FOV: 45 degrees; color fundus image
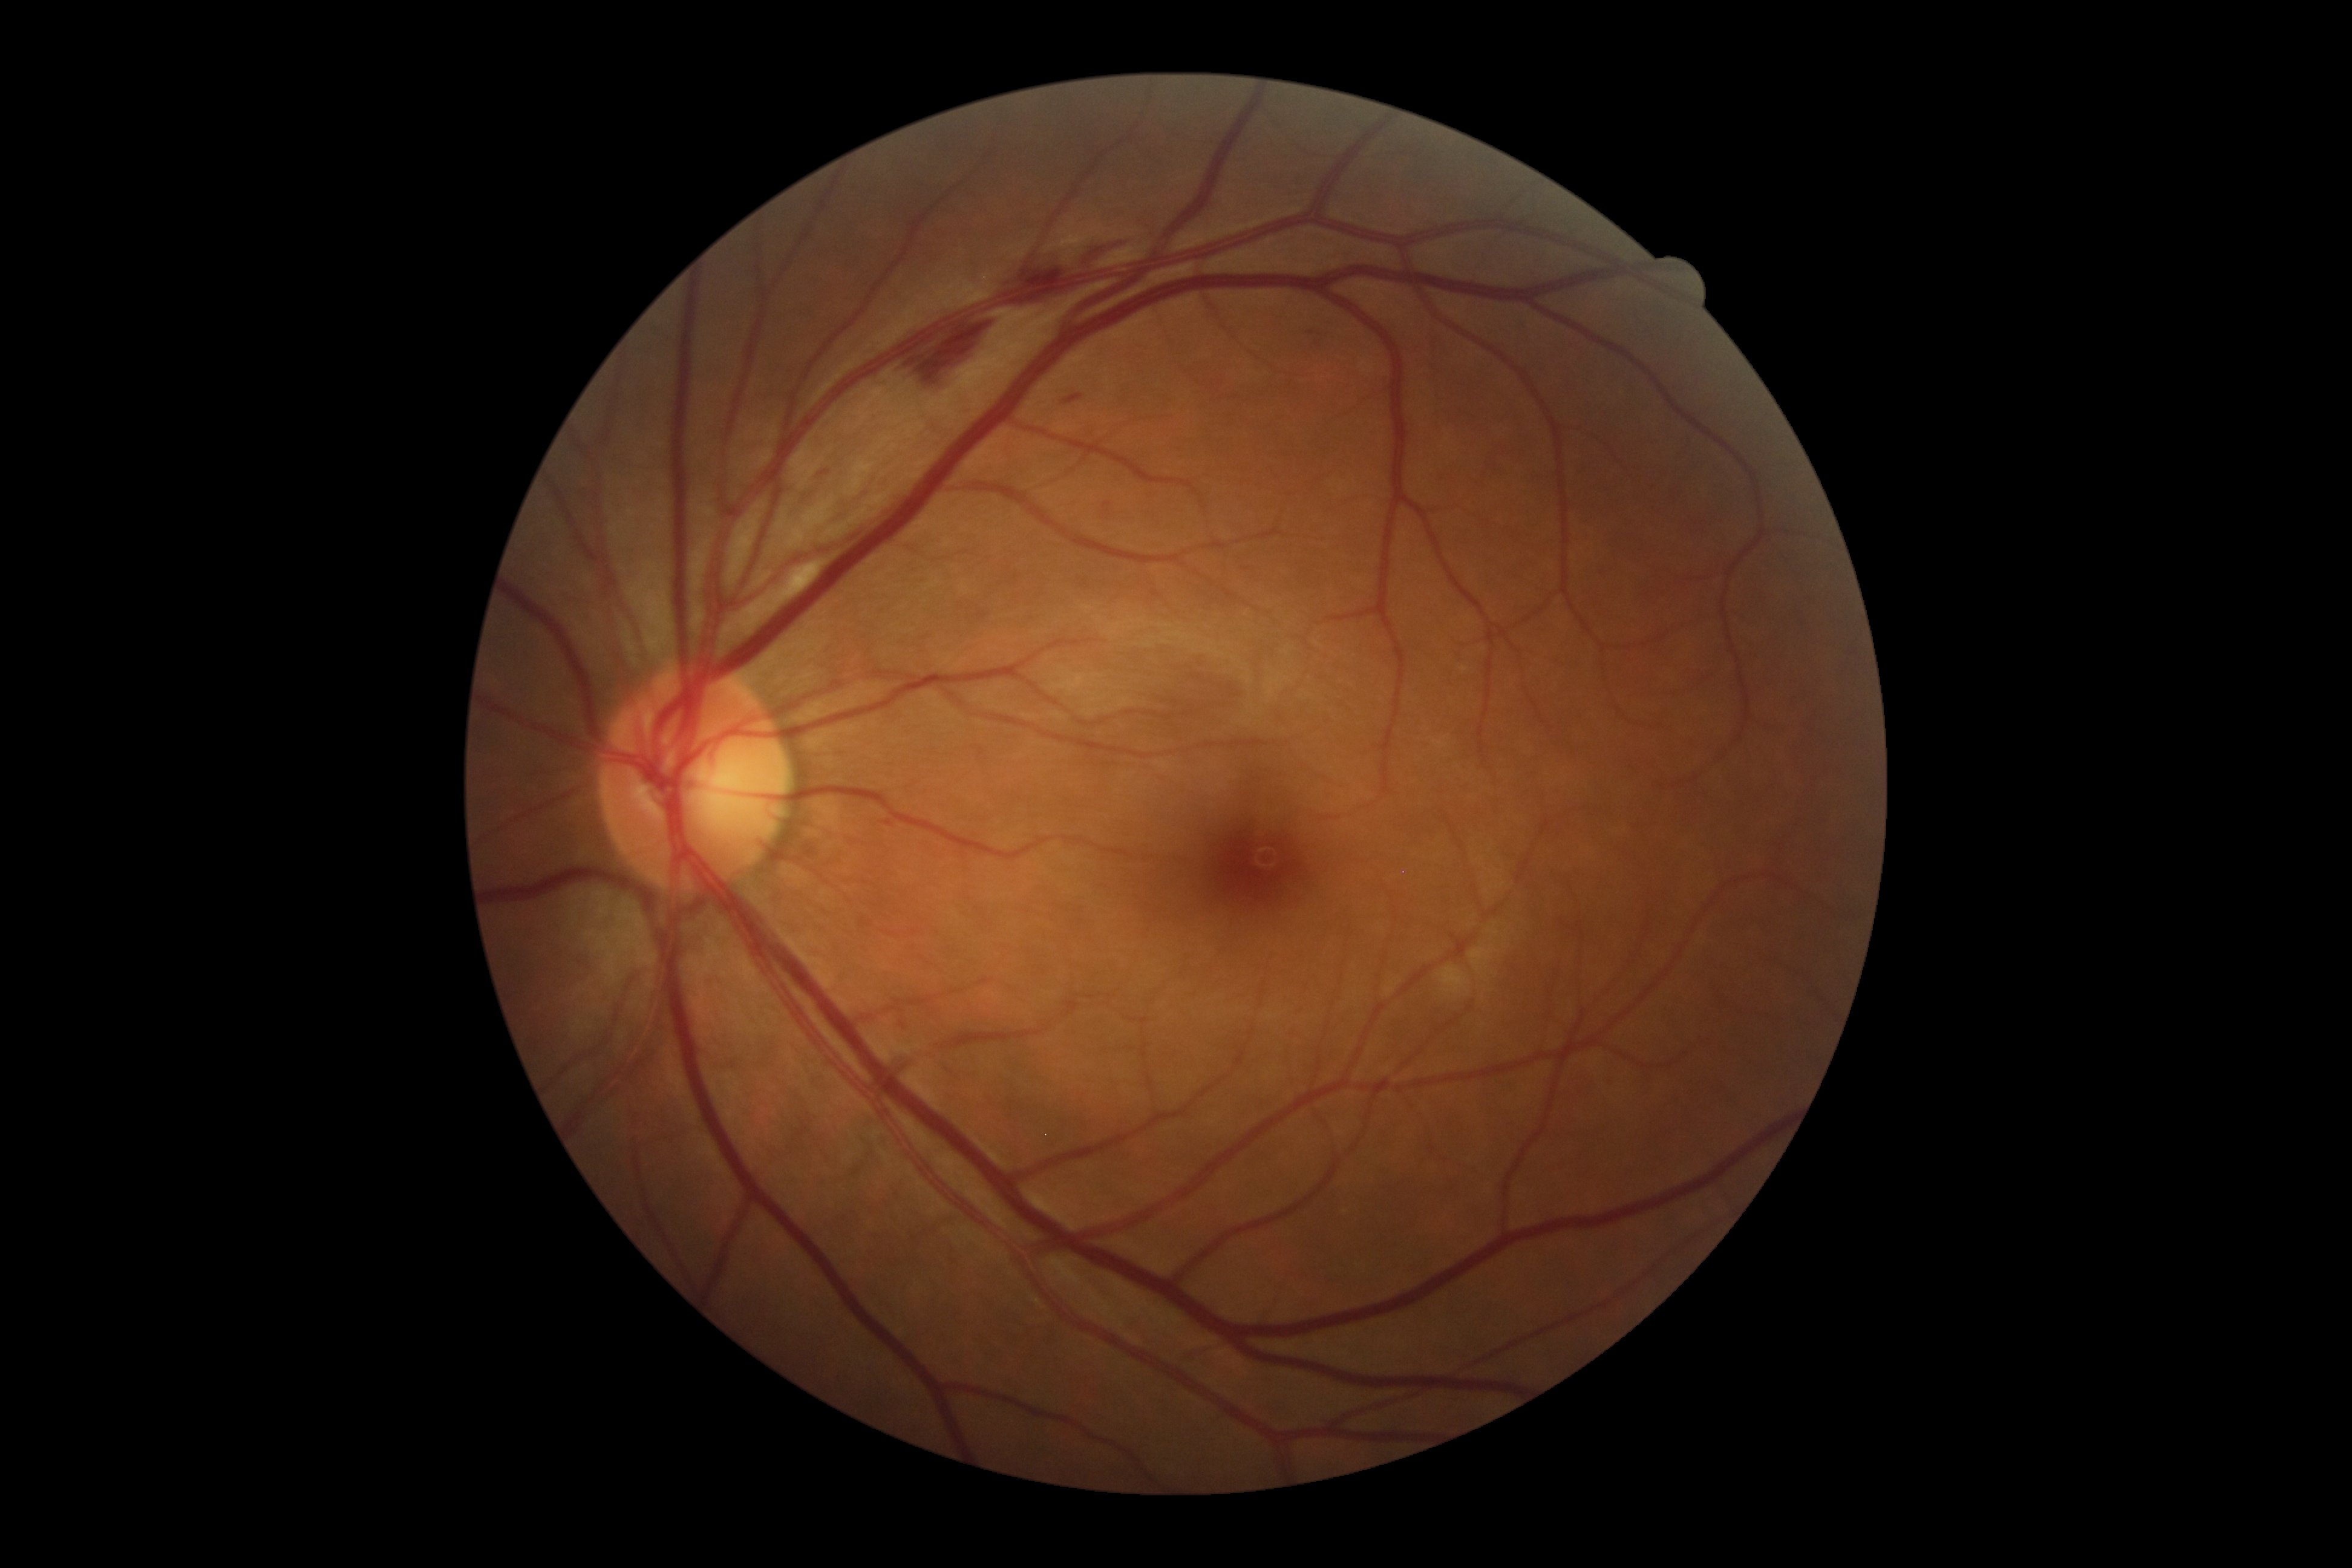
DR class: non-proliferative diabetic retinopathy. Retinopathy is grade 2 (moderate NPDR) — more than just microaneurysms but less than severe NPDR.